Wide-field contact fundus photograph of an infant: 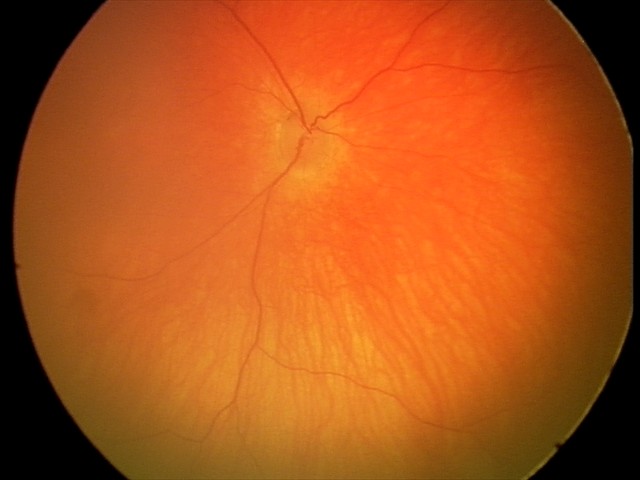
Physiological retinal appearance for postconceptual age.